Color fundus photograph, 45° FOV:
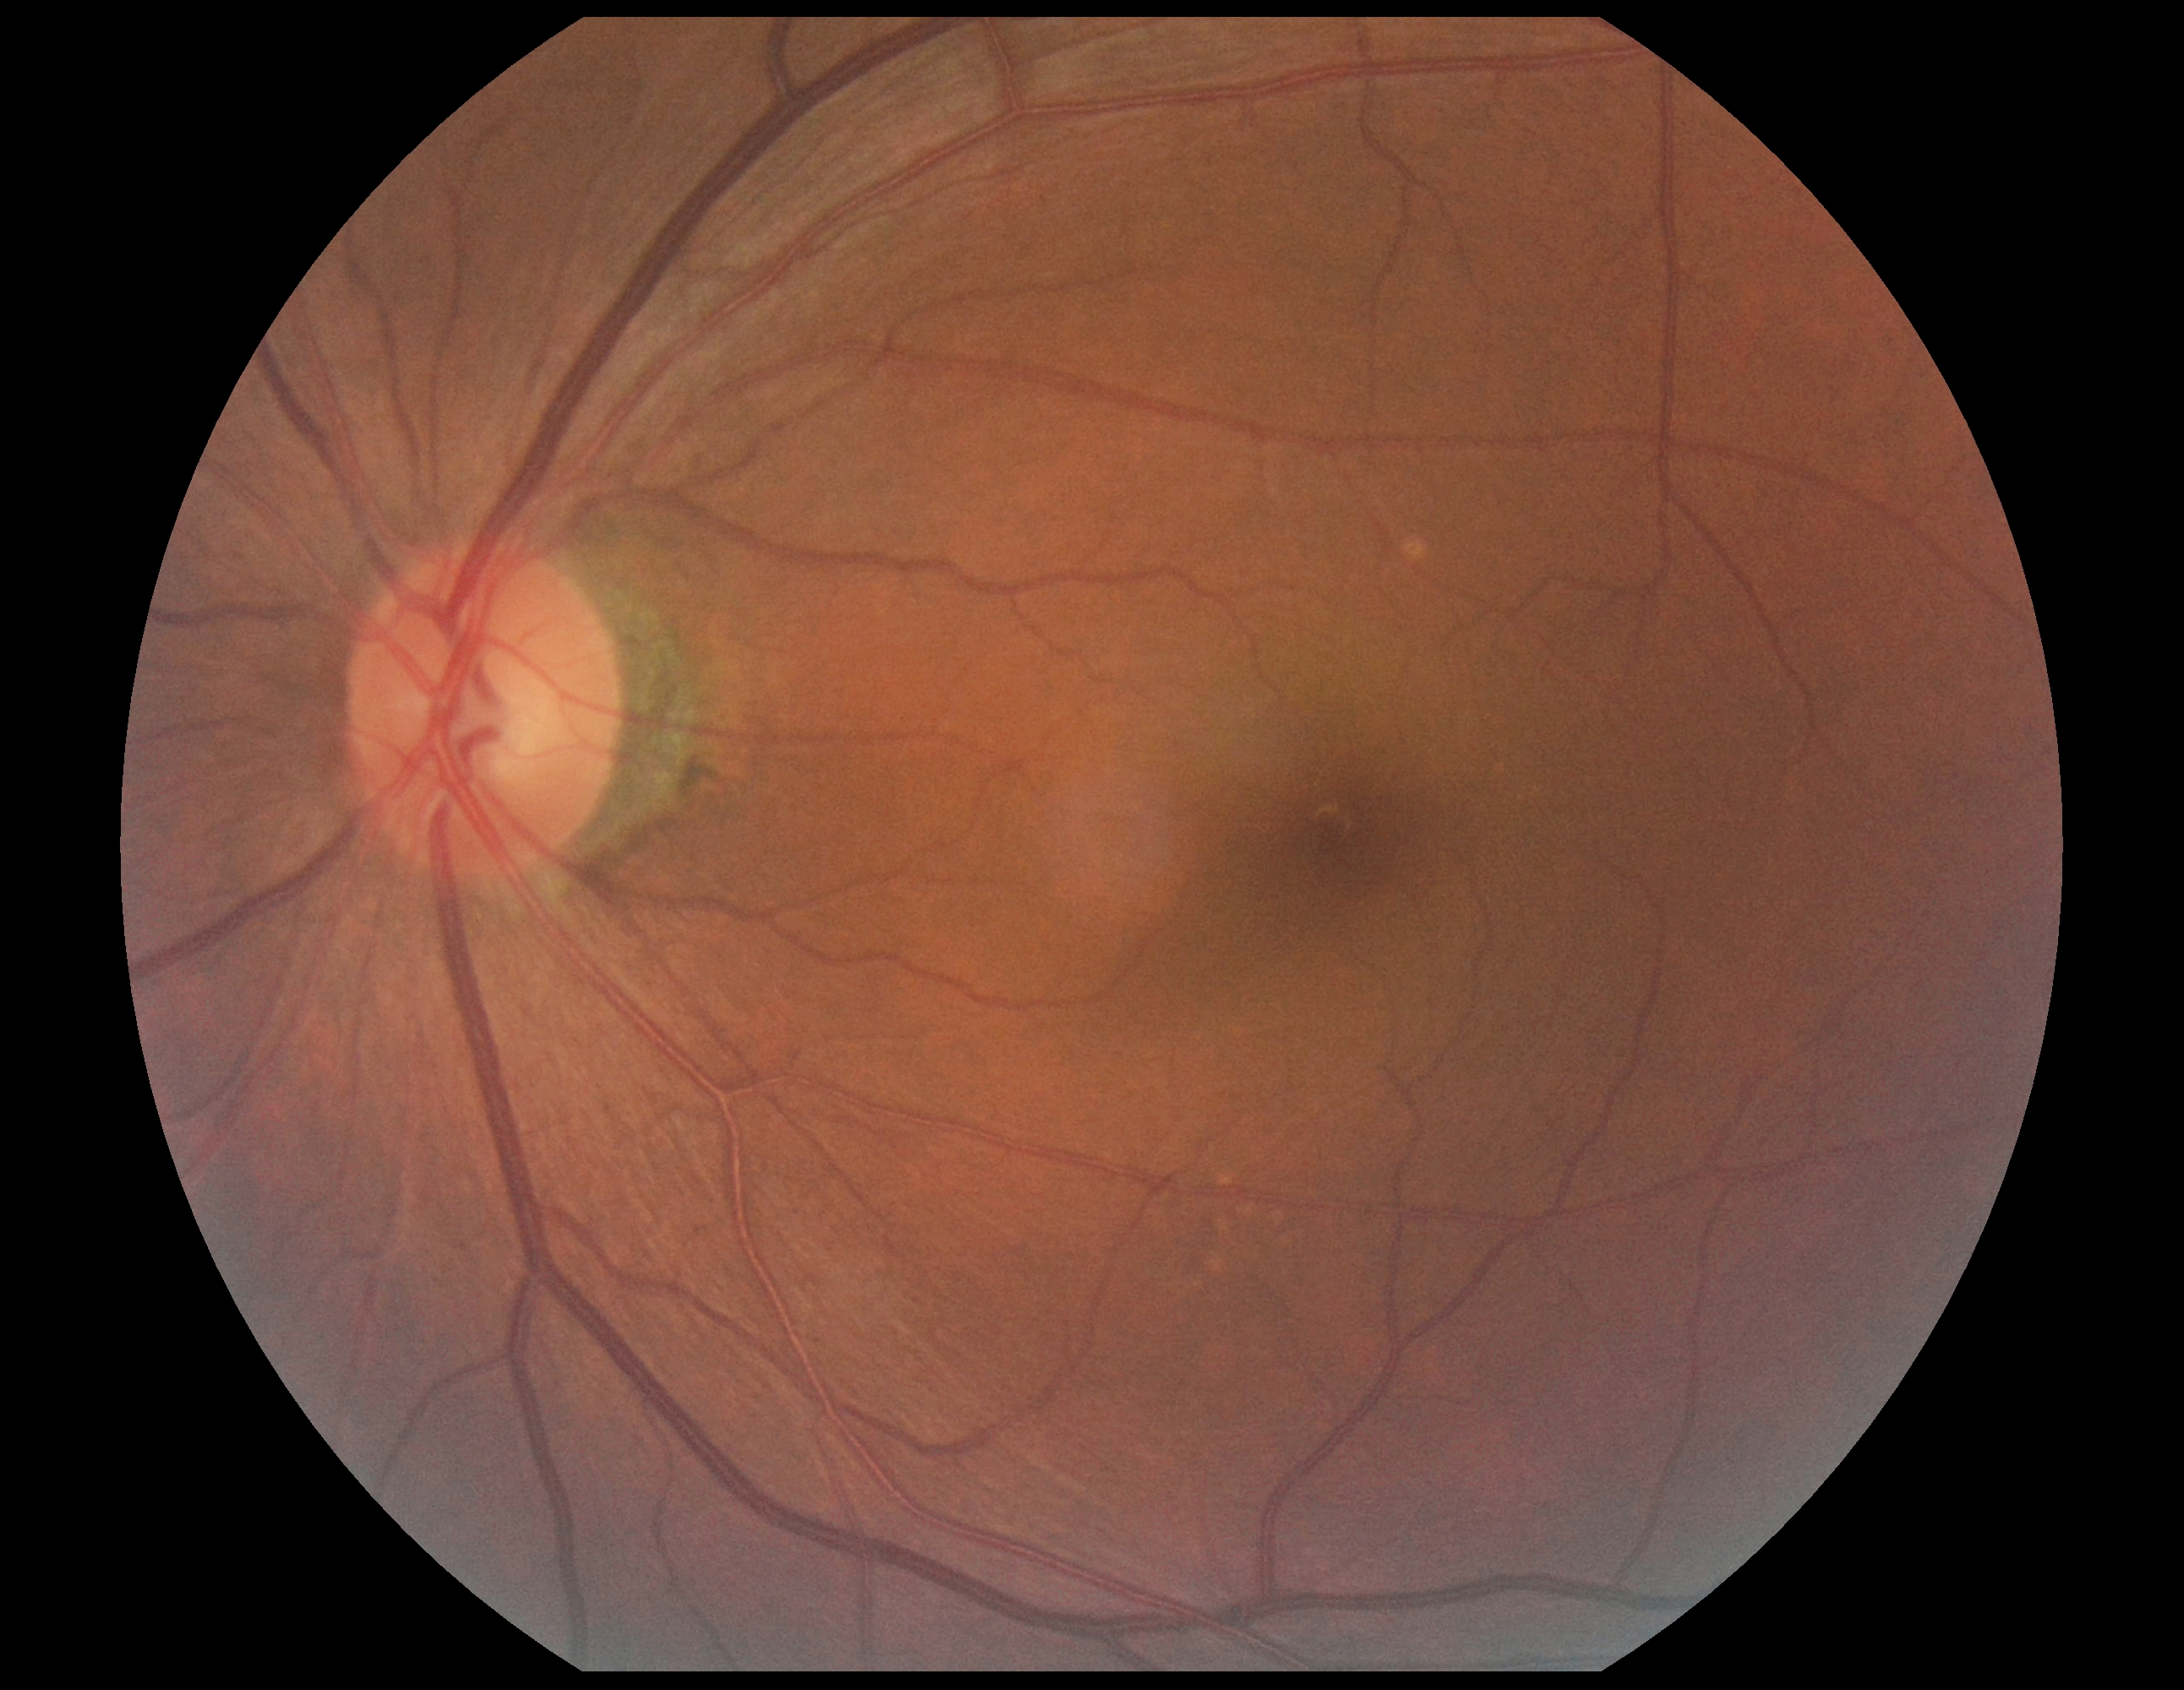 DR impression = negative for DR
DR severity = grade 0 (no apparent retinopathy)